Modified Davis classification, 848x848px — 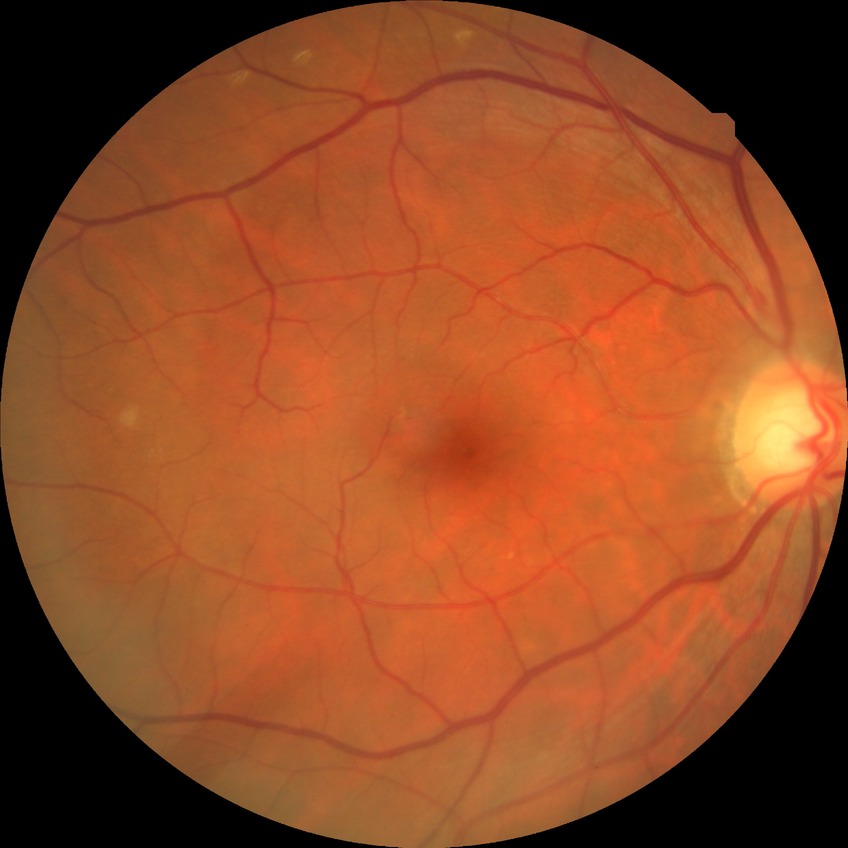   davis_grade: NDR
  dr_impression: no apparent DR